Infant wide-field fundus photograph.
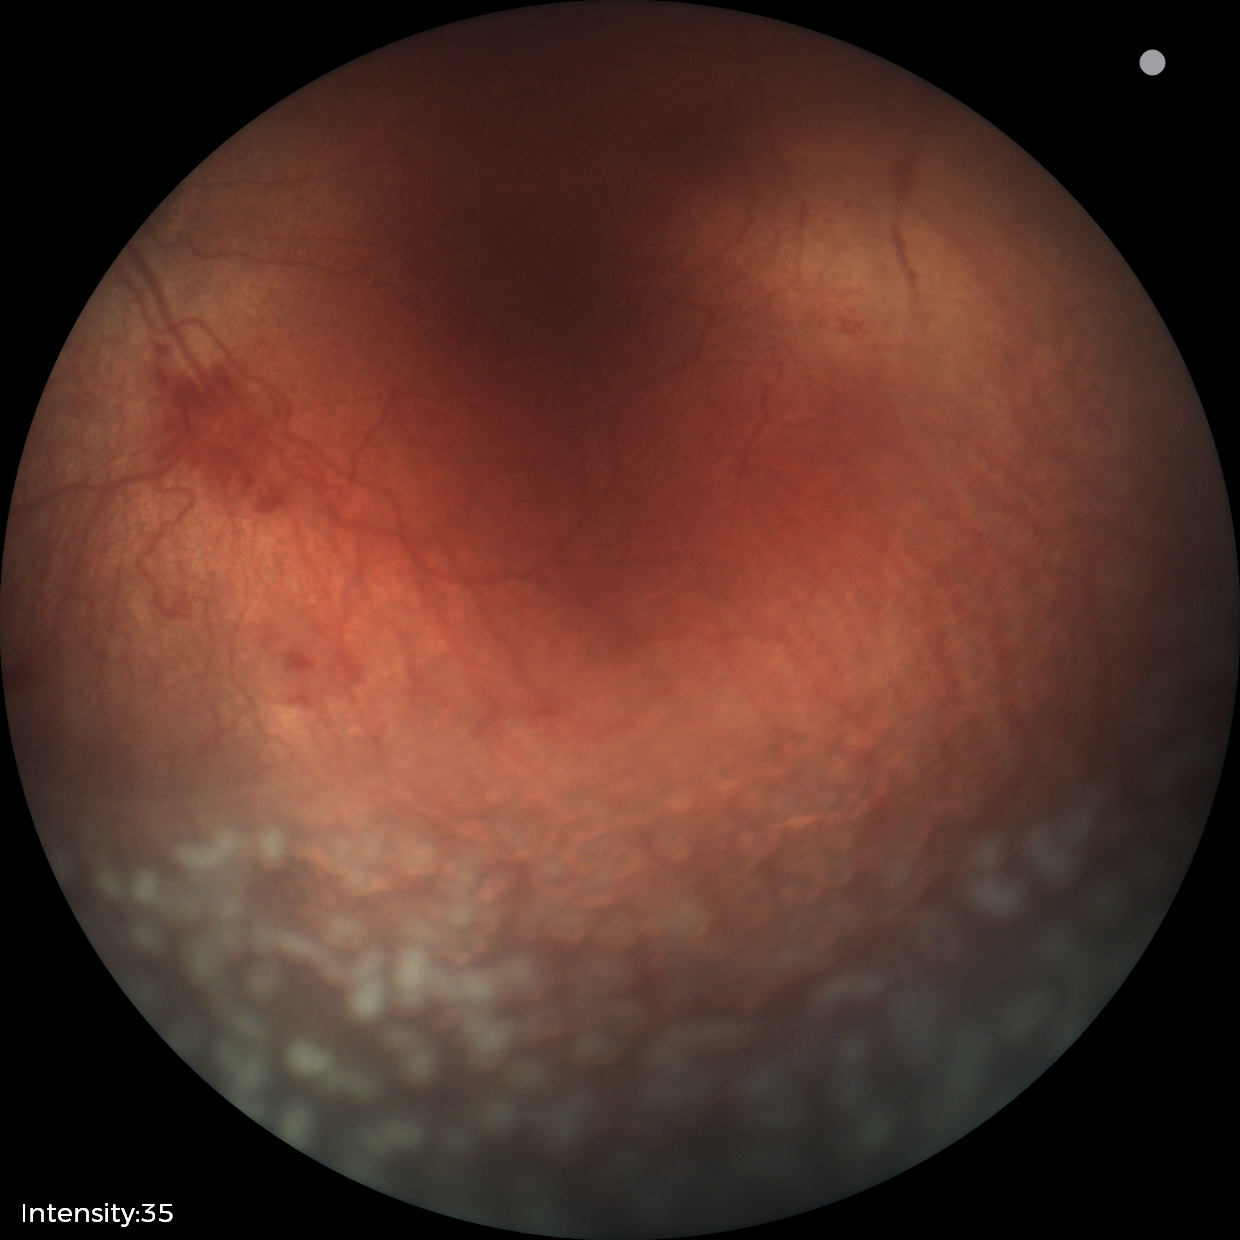 Series diagnosed as ROP stage 2.